45-degree field of view.
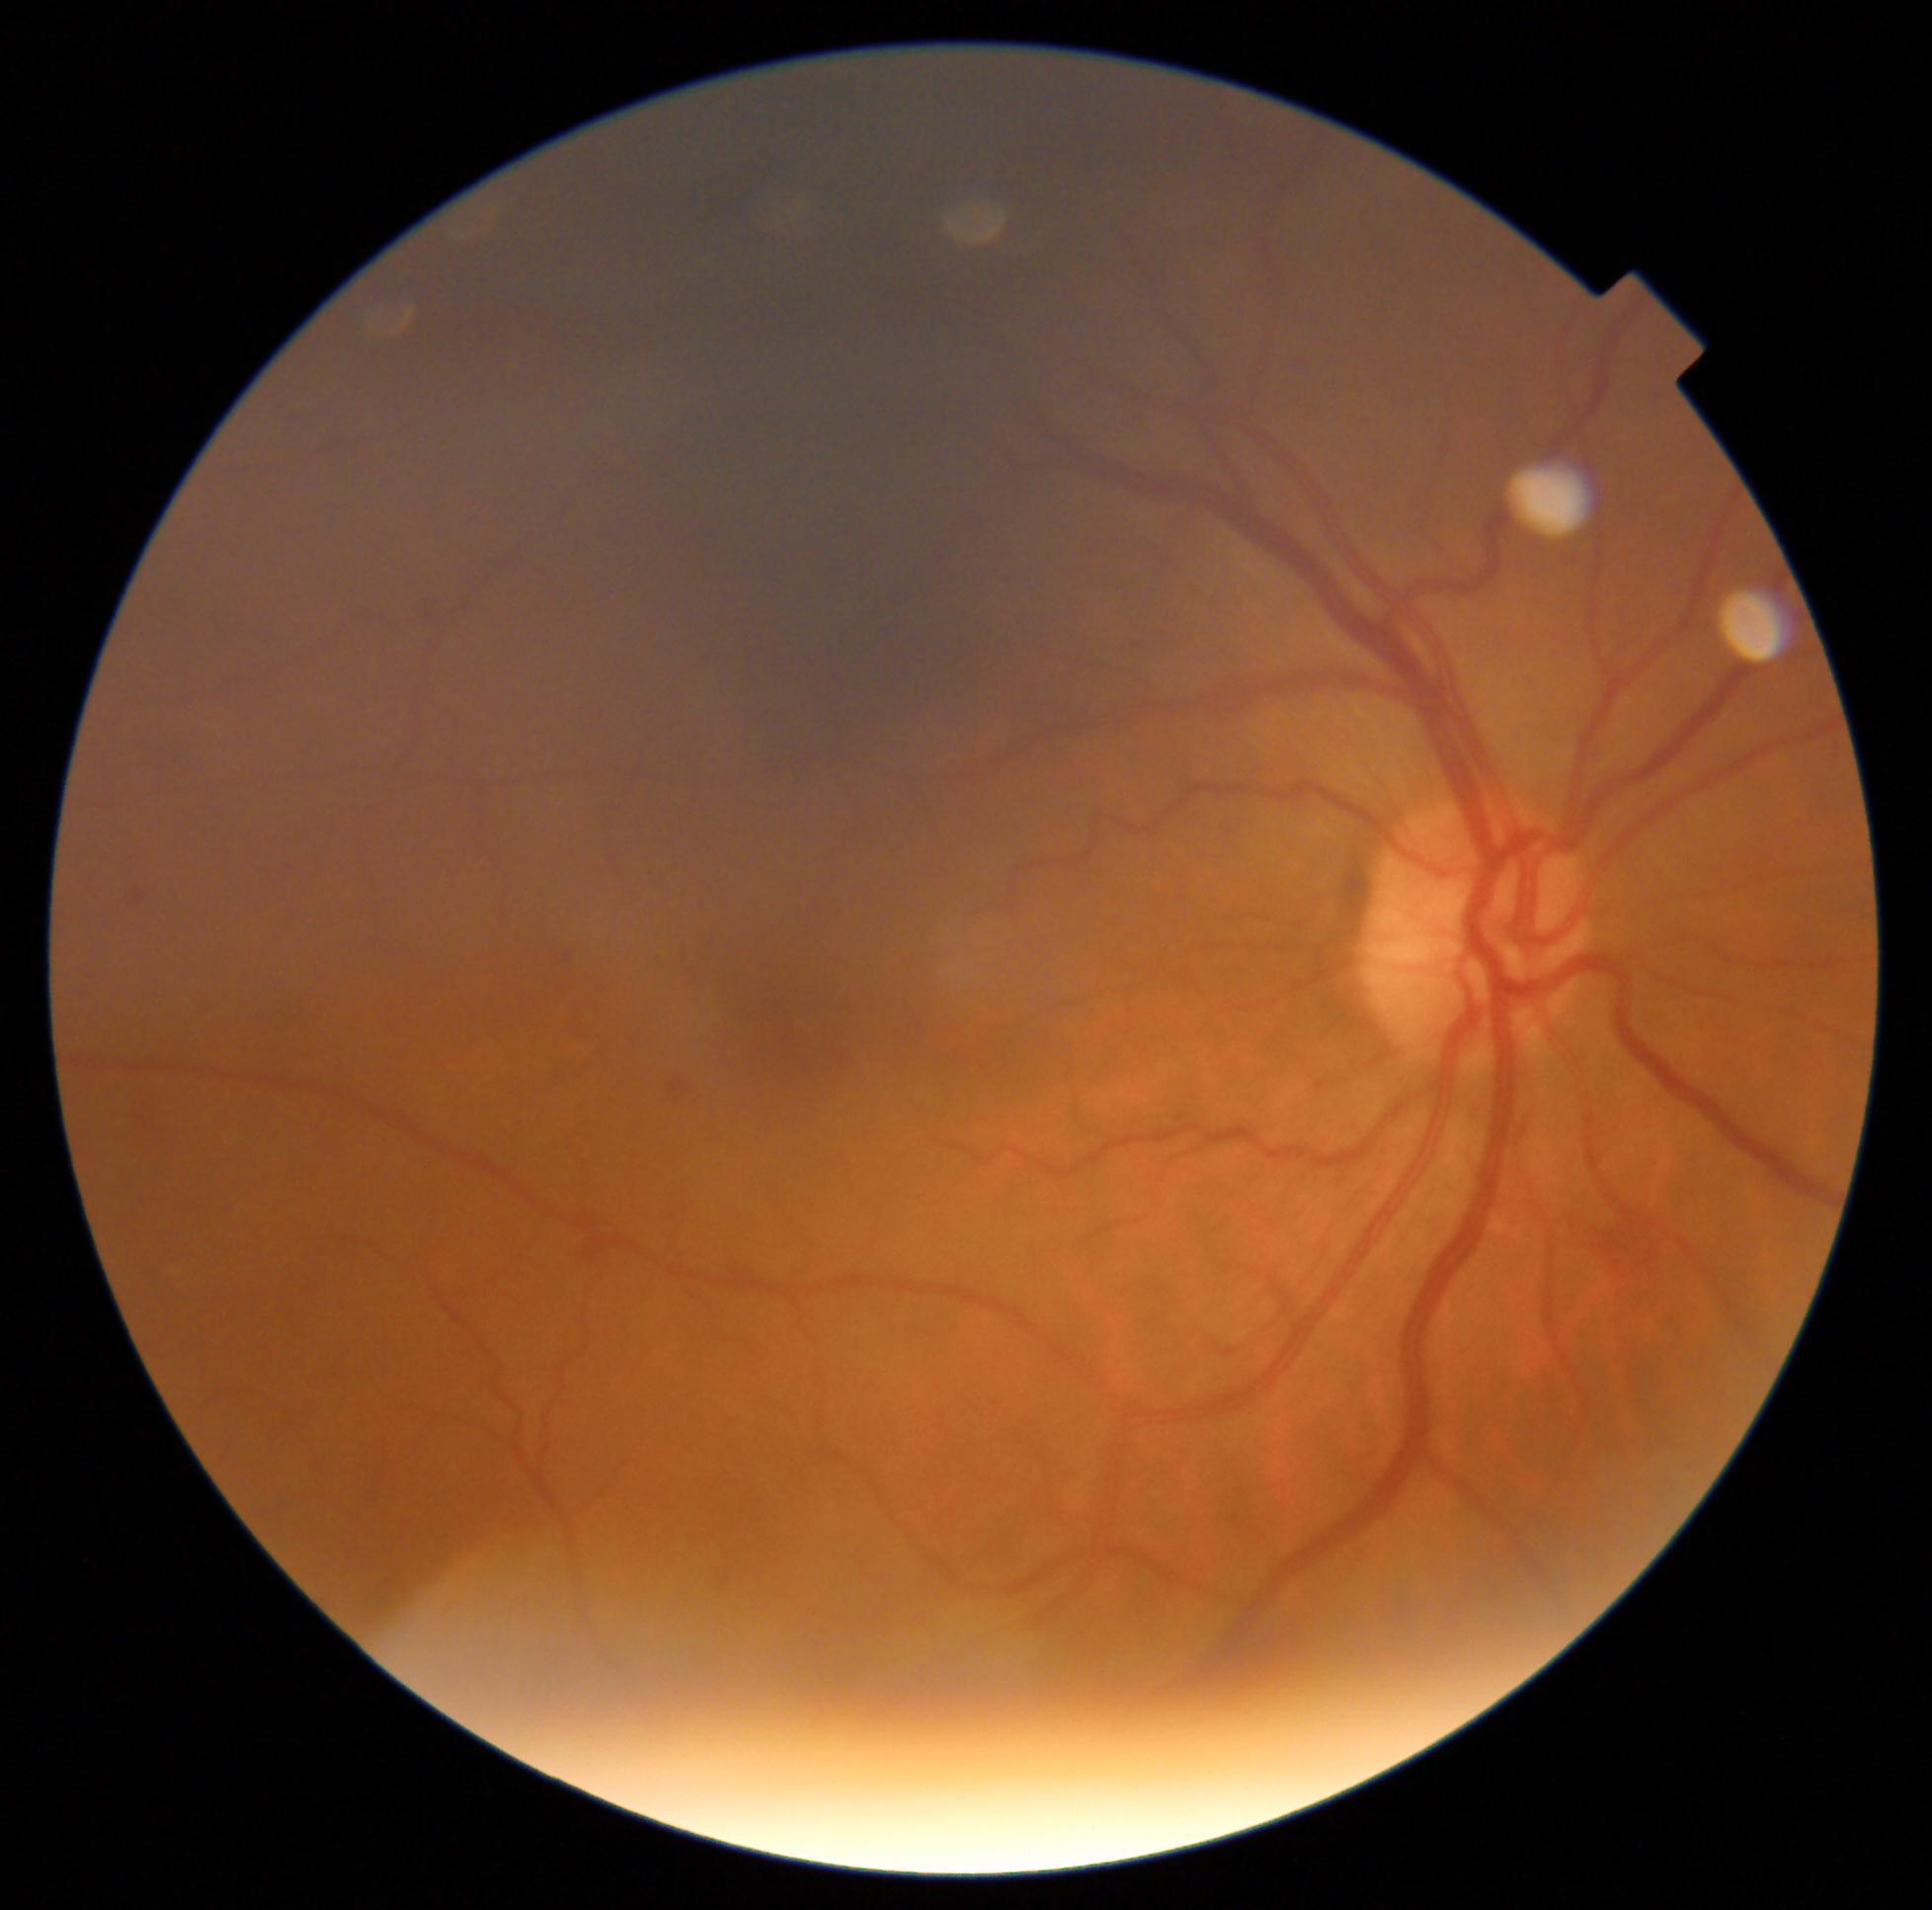 Findings:
- DR severity: moderate NPDR (grade 2)